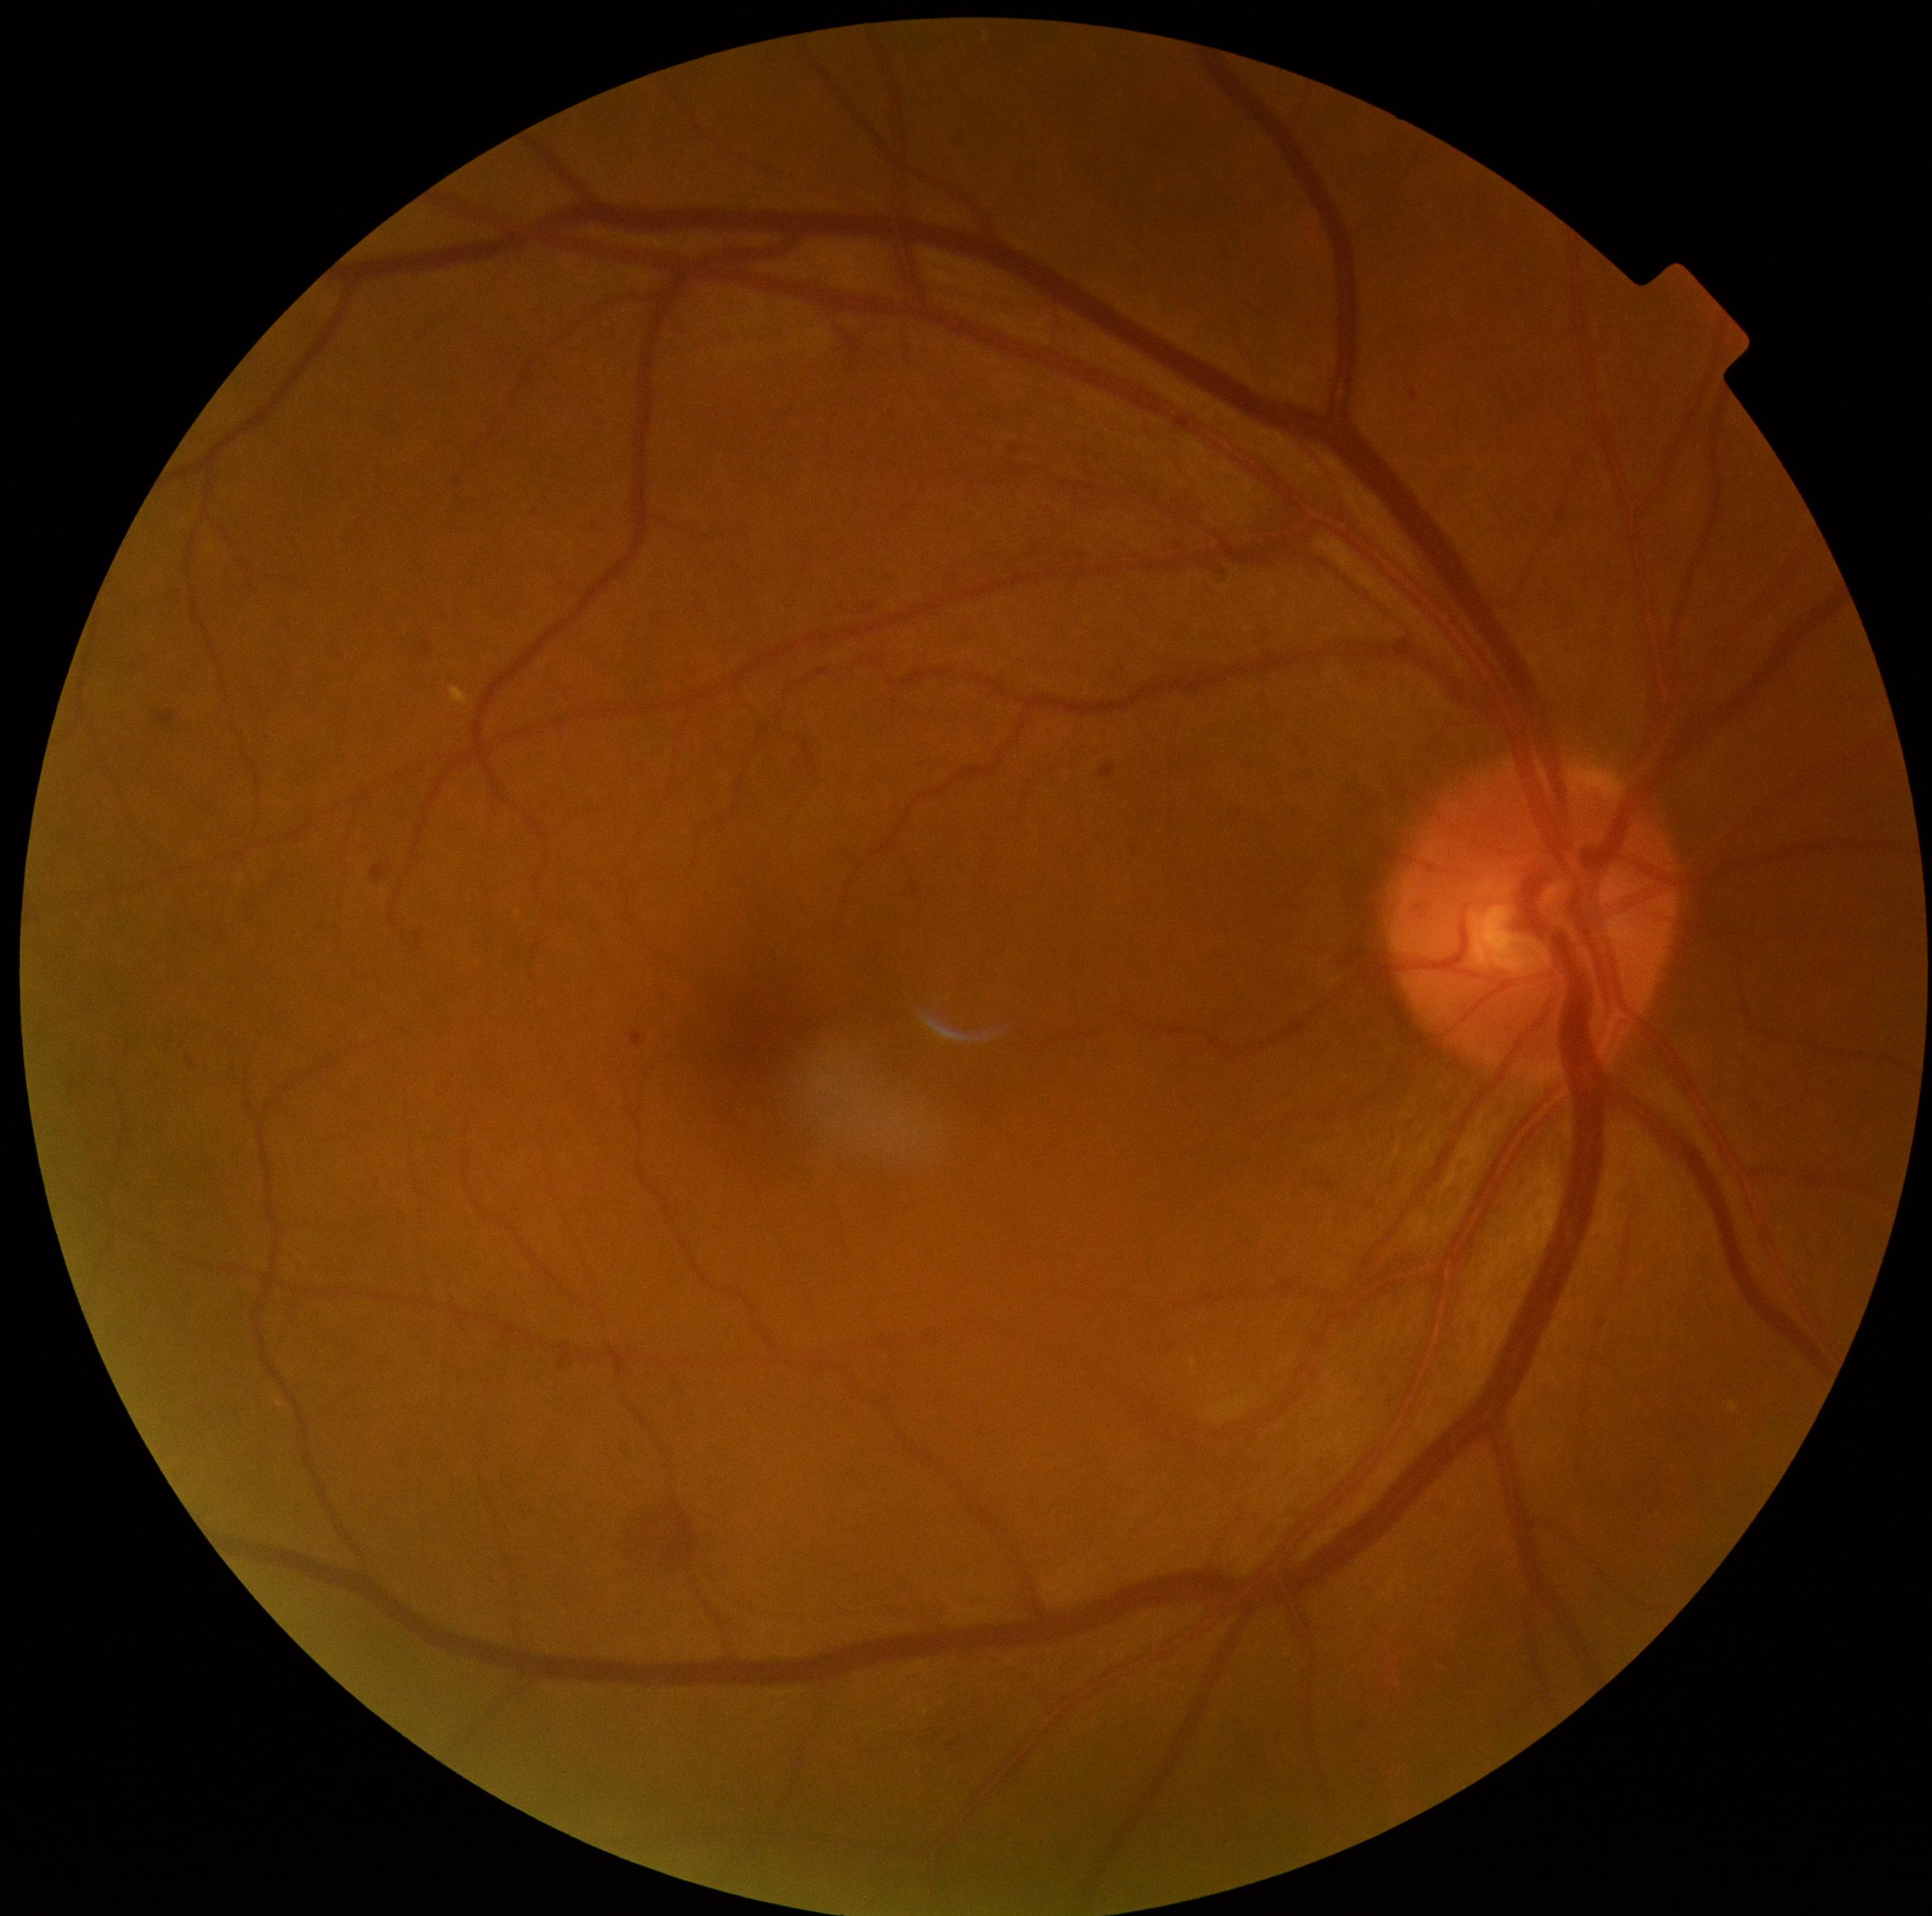

DR: moderate NPDR (grade 2).